Corneal thickness 584 µm; undilated pupil; optic disc-centered; image size 2212x1661:
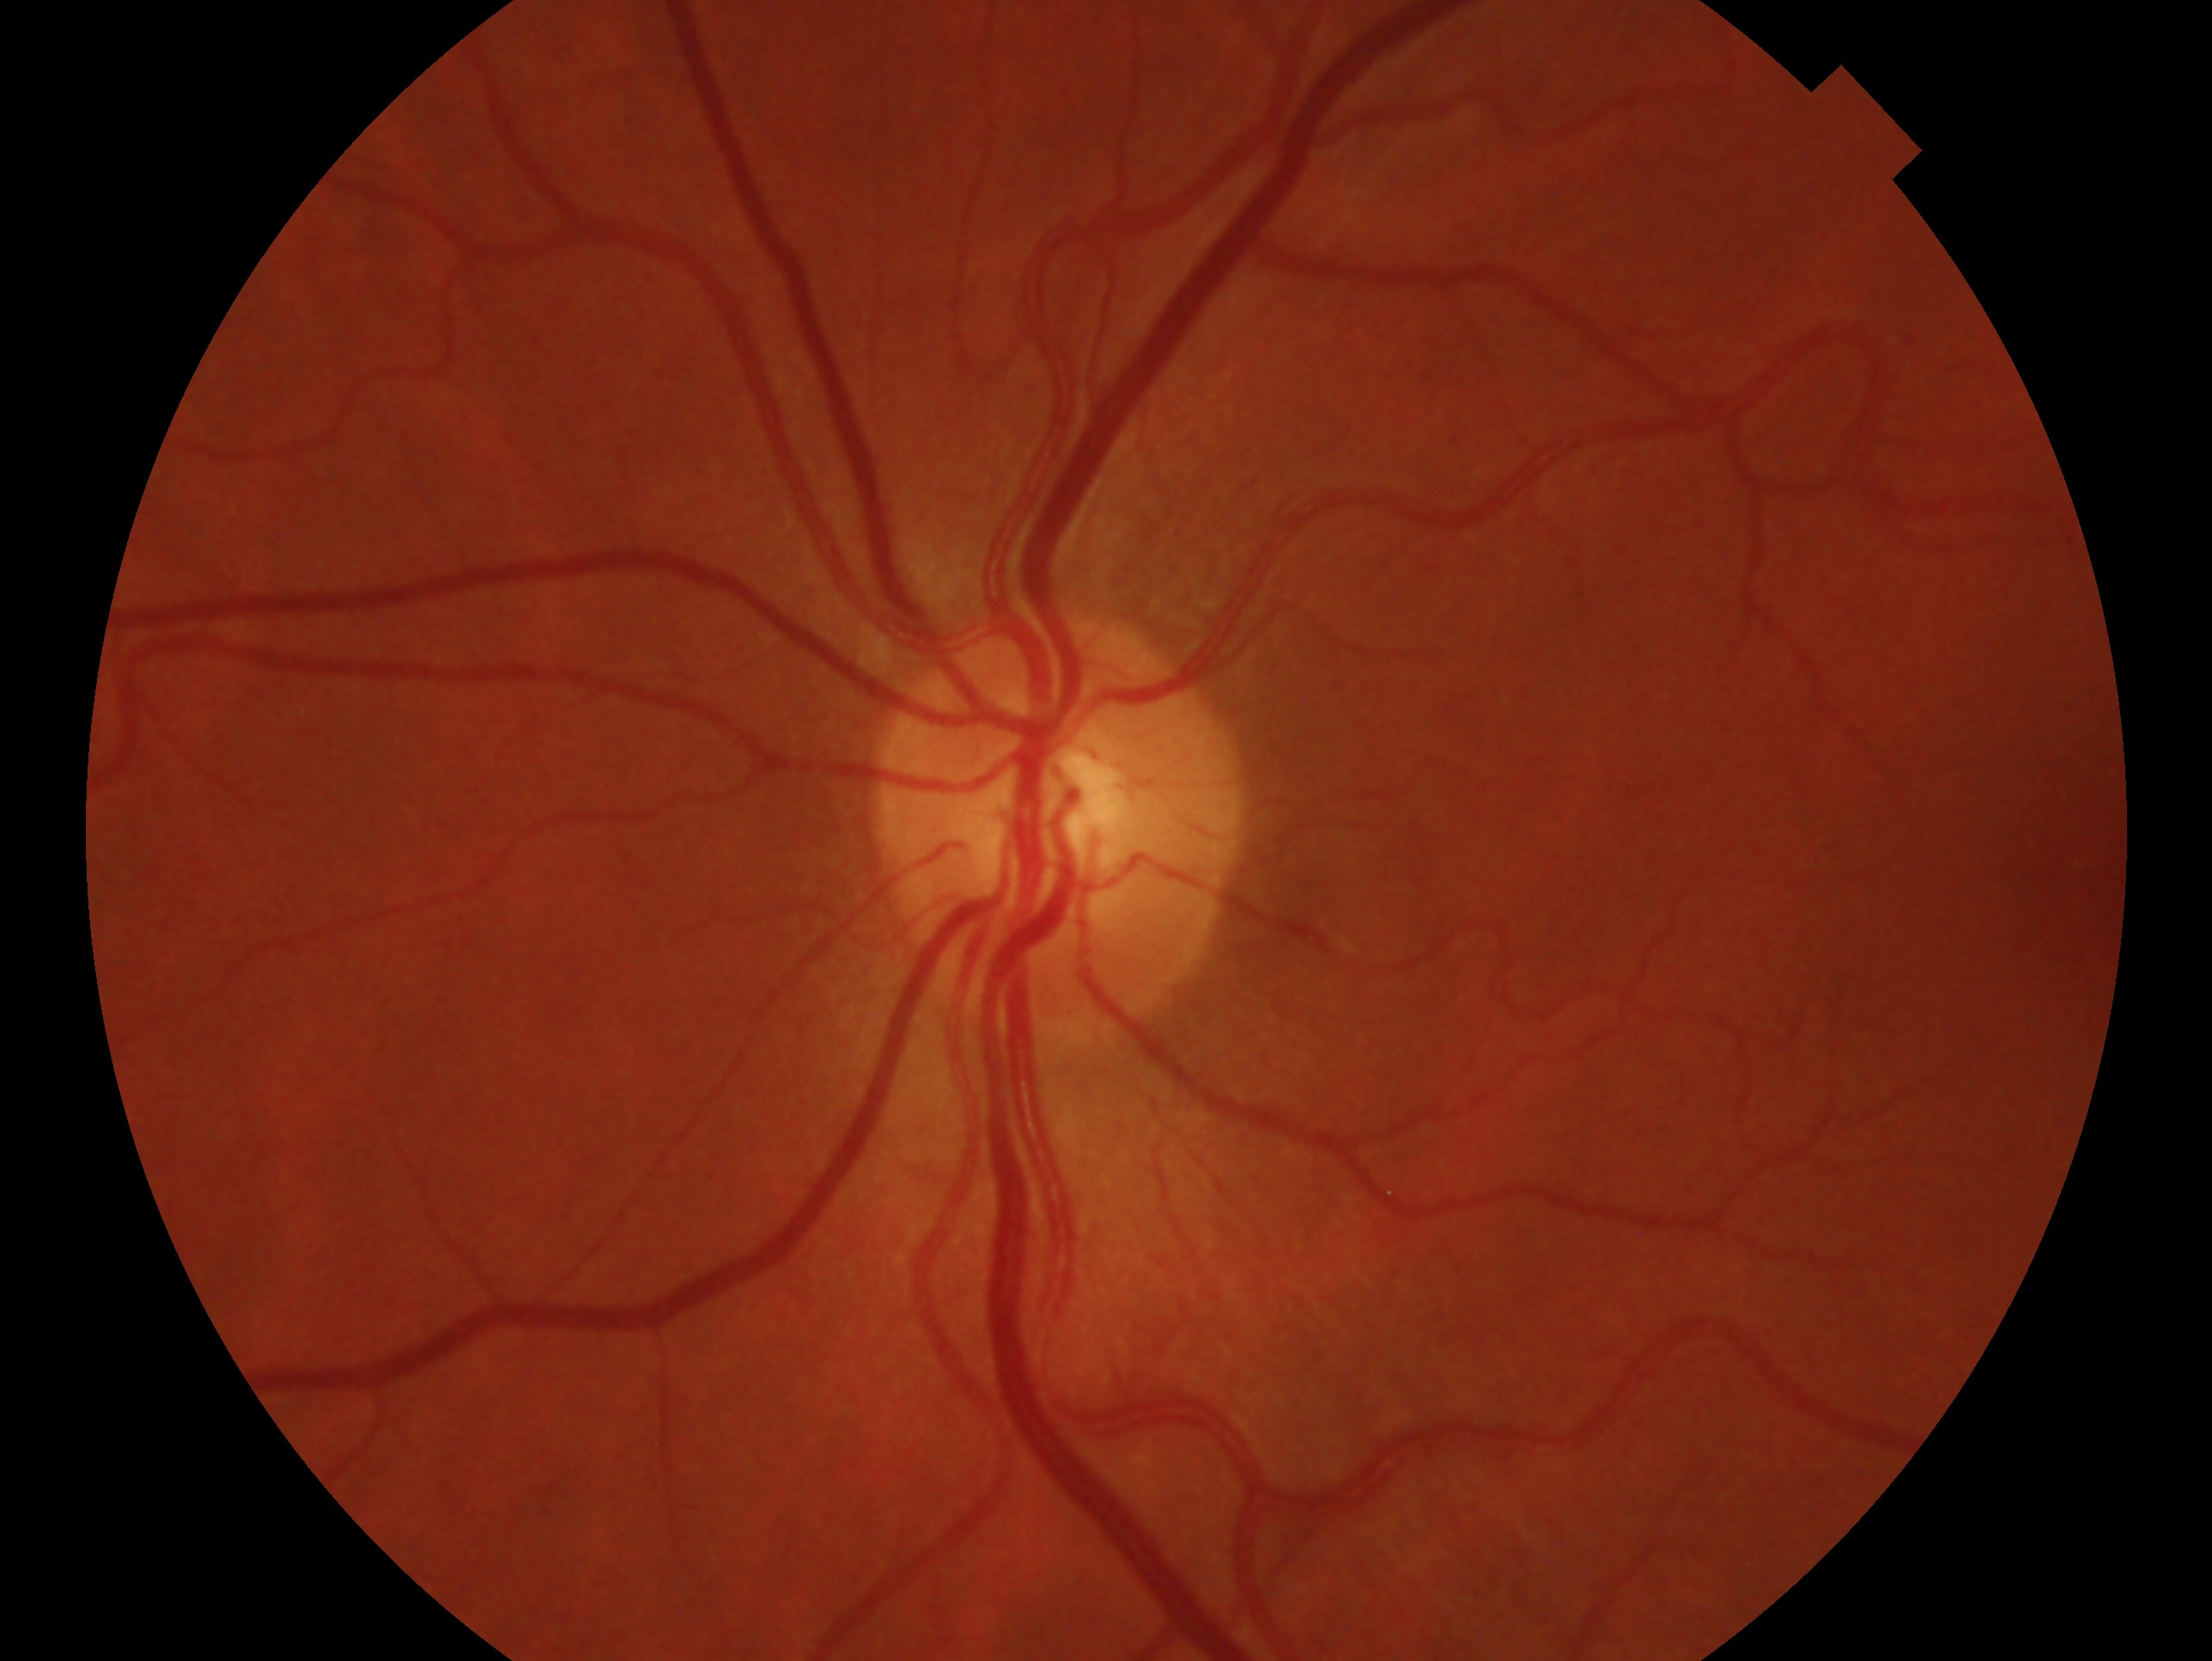
Glaucoma assessment: no signs of glaucoma. Eye: oculus sinister.